Wide-field retinal mosaic image: 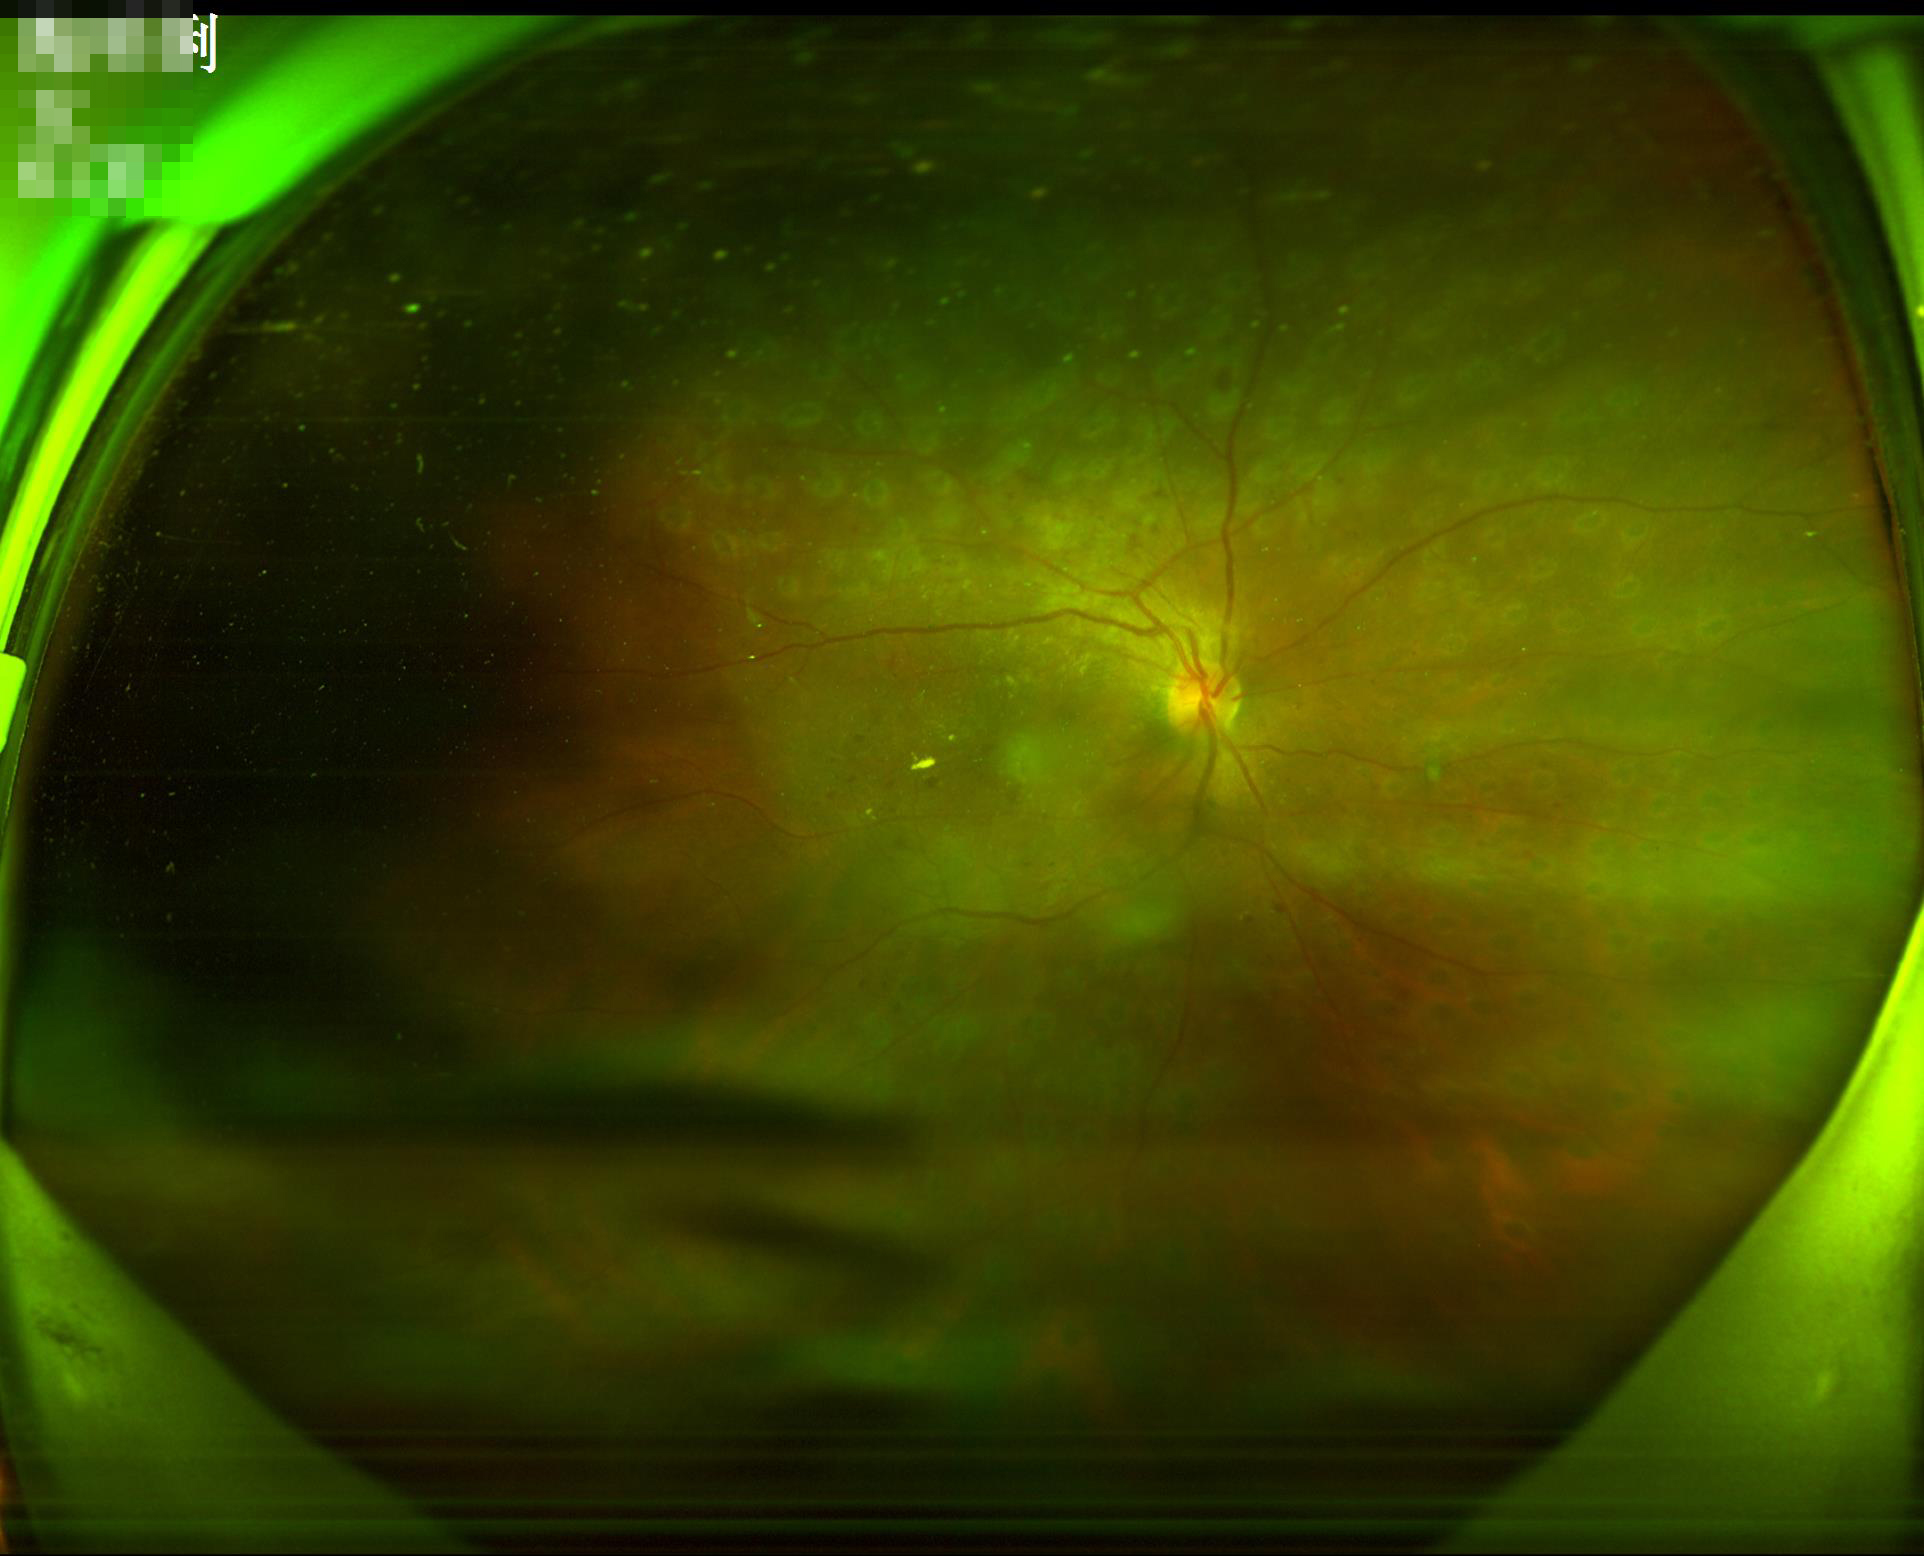
Good dynamic range. Image quality is inadequate for diagnostic use. Illumination and color are suboptimal. Out of focus; structures are indistinct.